Wide-field fundus photograph from neonatal ROP screening. Acquired on the Clarity RetCam 3: 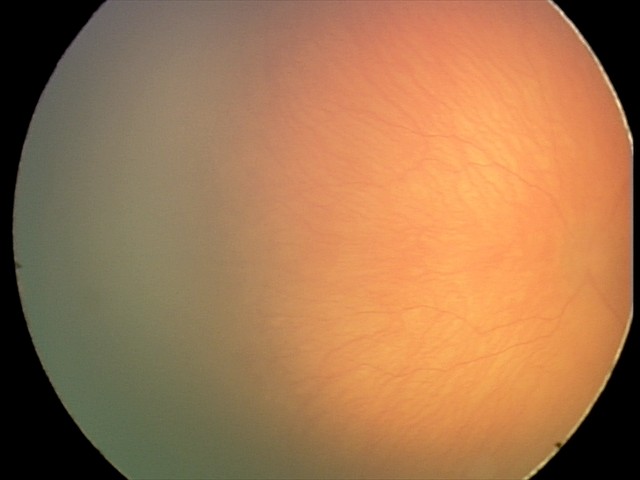

Screening series with aggressive retinopathy of prematurity.